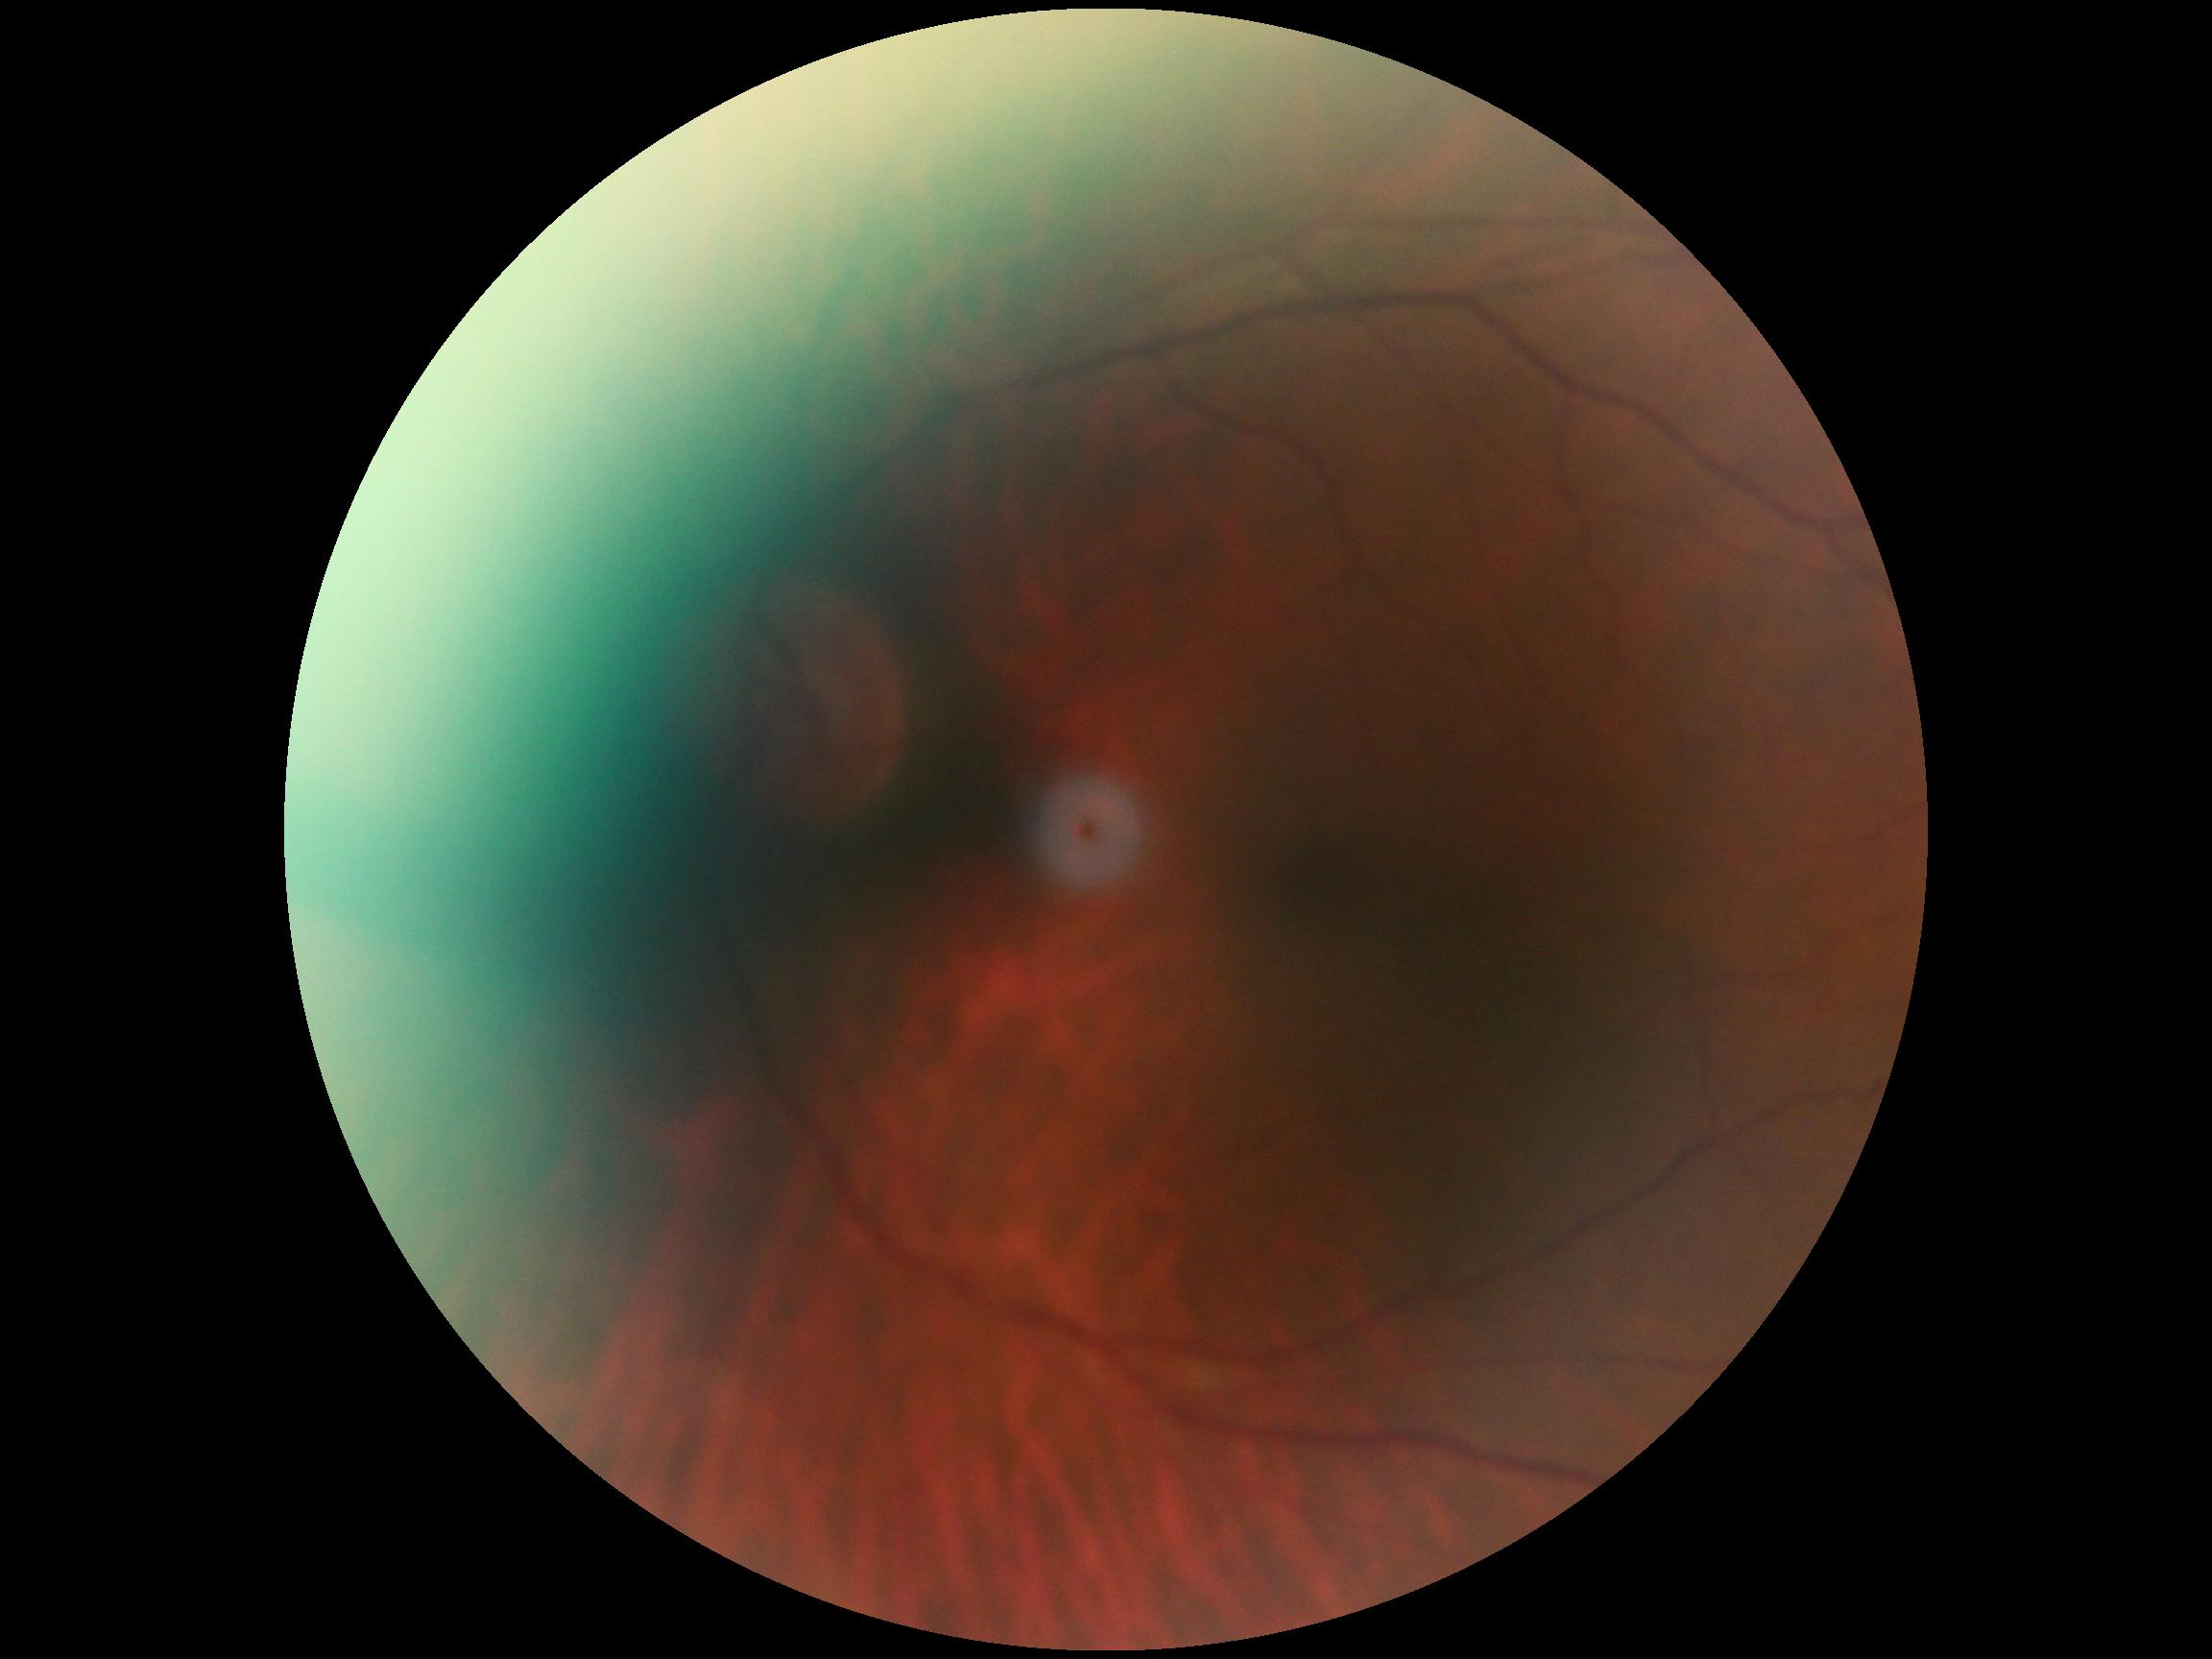 DR grade is 0.